No pharmacologic dilation. 45° FOV. NIDEK AFC-230. Graded on the modified Davis scale. Image size 848x848 — 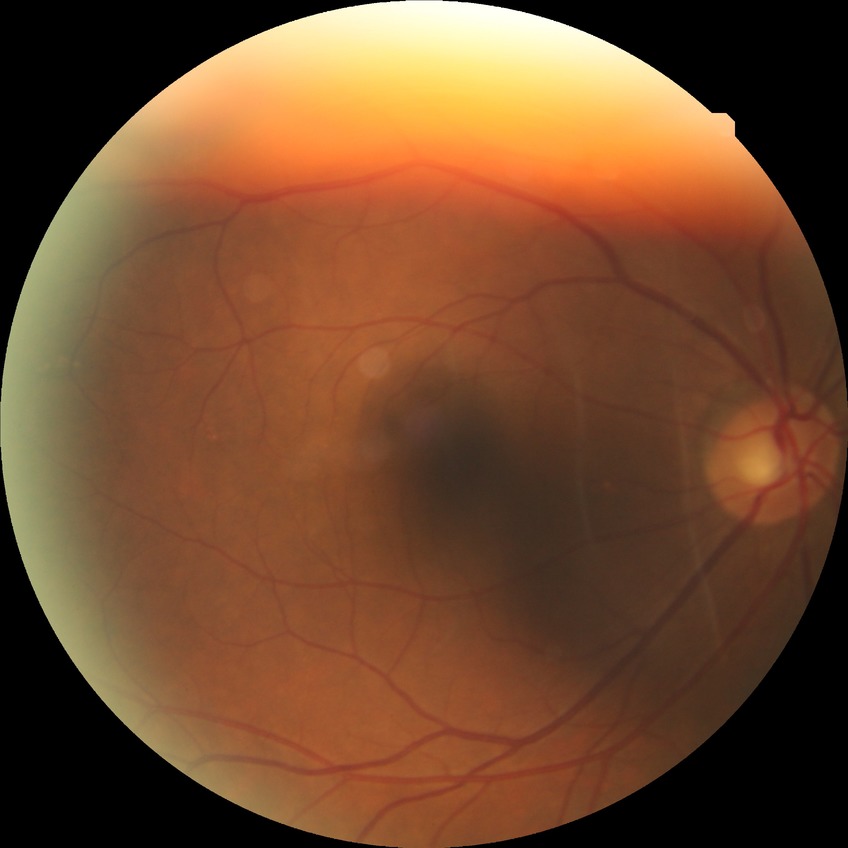
diabetic retinopathy (DR): NDR (no diabetic retinopathy).